512 by 512 pixels — 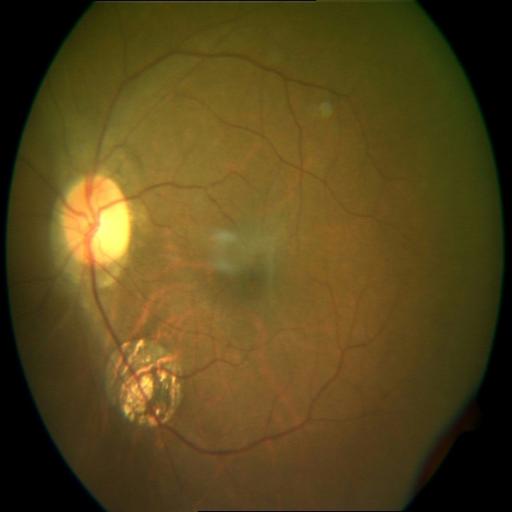

Diagnosis: macular scar.